Color fundus photograph; 2352 x 1568 pixels — 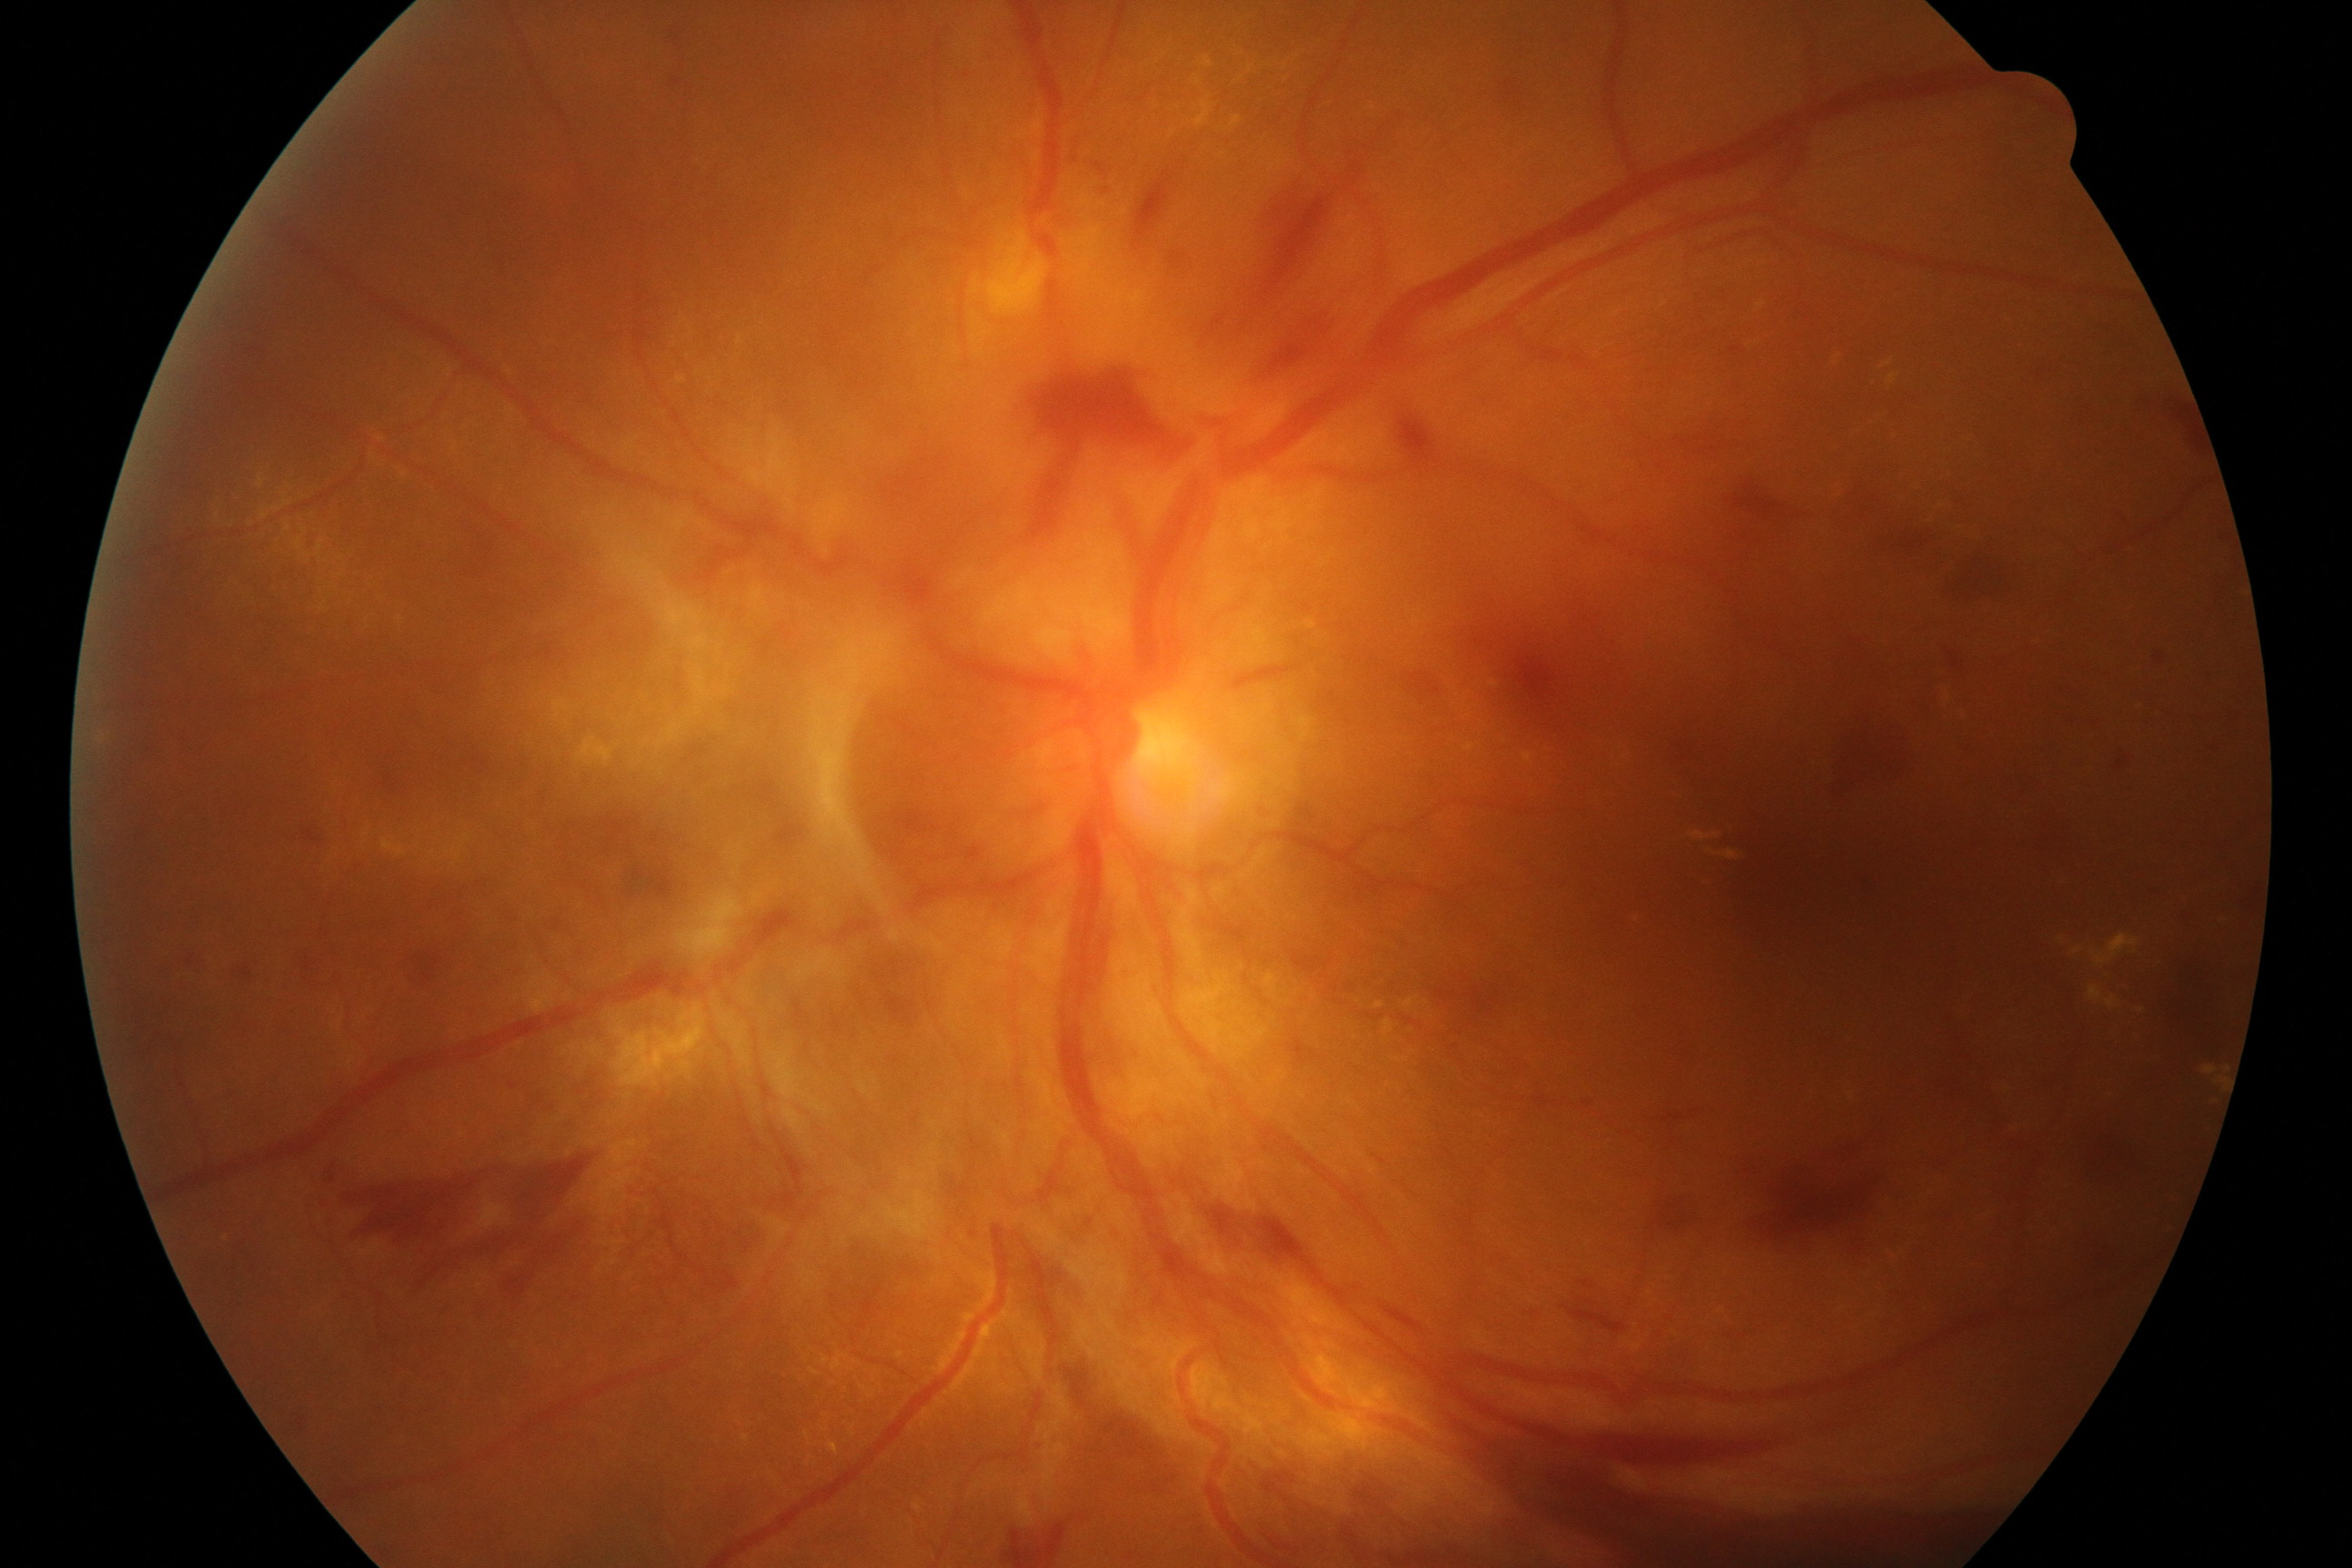
Consistent with severe non-proliferative or proliferative diabetic retinopathy.